Infant wide-field fundus photograph; Clarity RetCam 3, 130° FOV; 640 by 480 pixels: 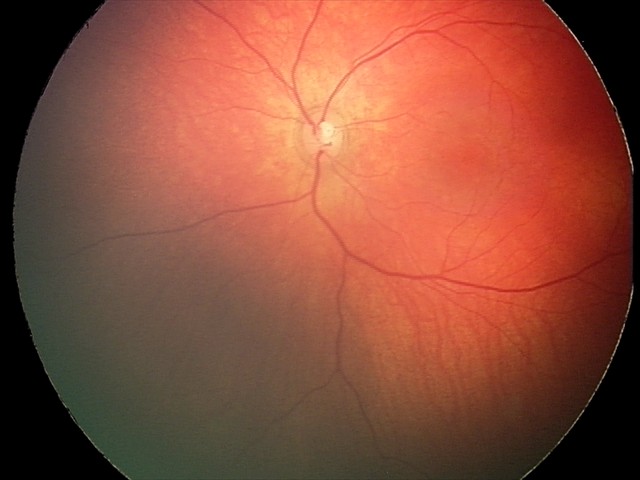
Screening: retinal hemorrhages.